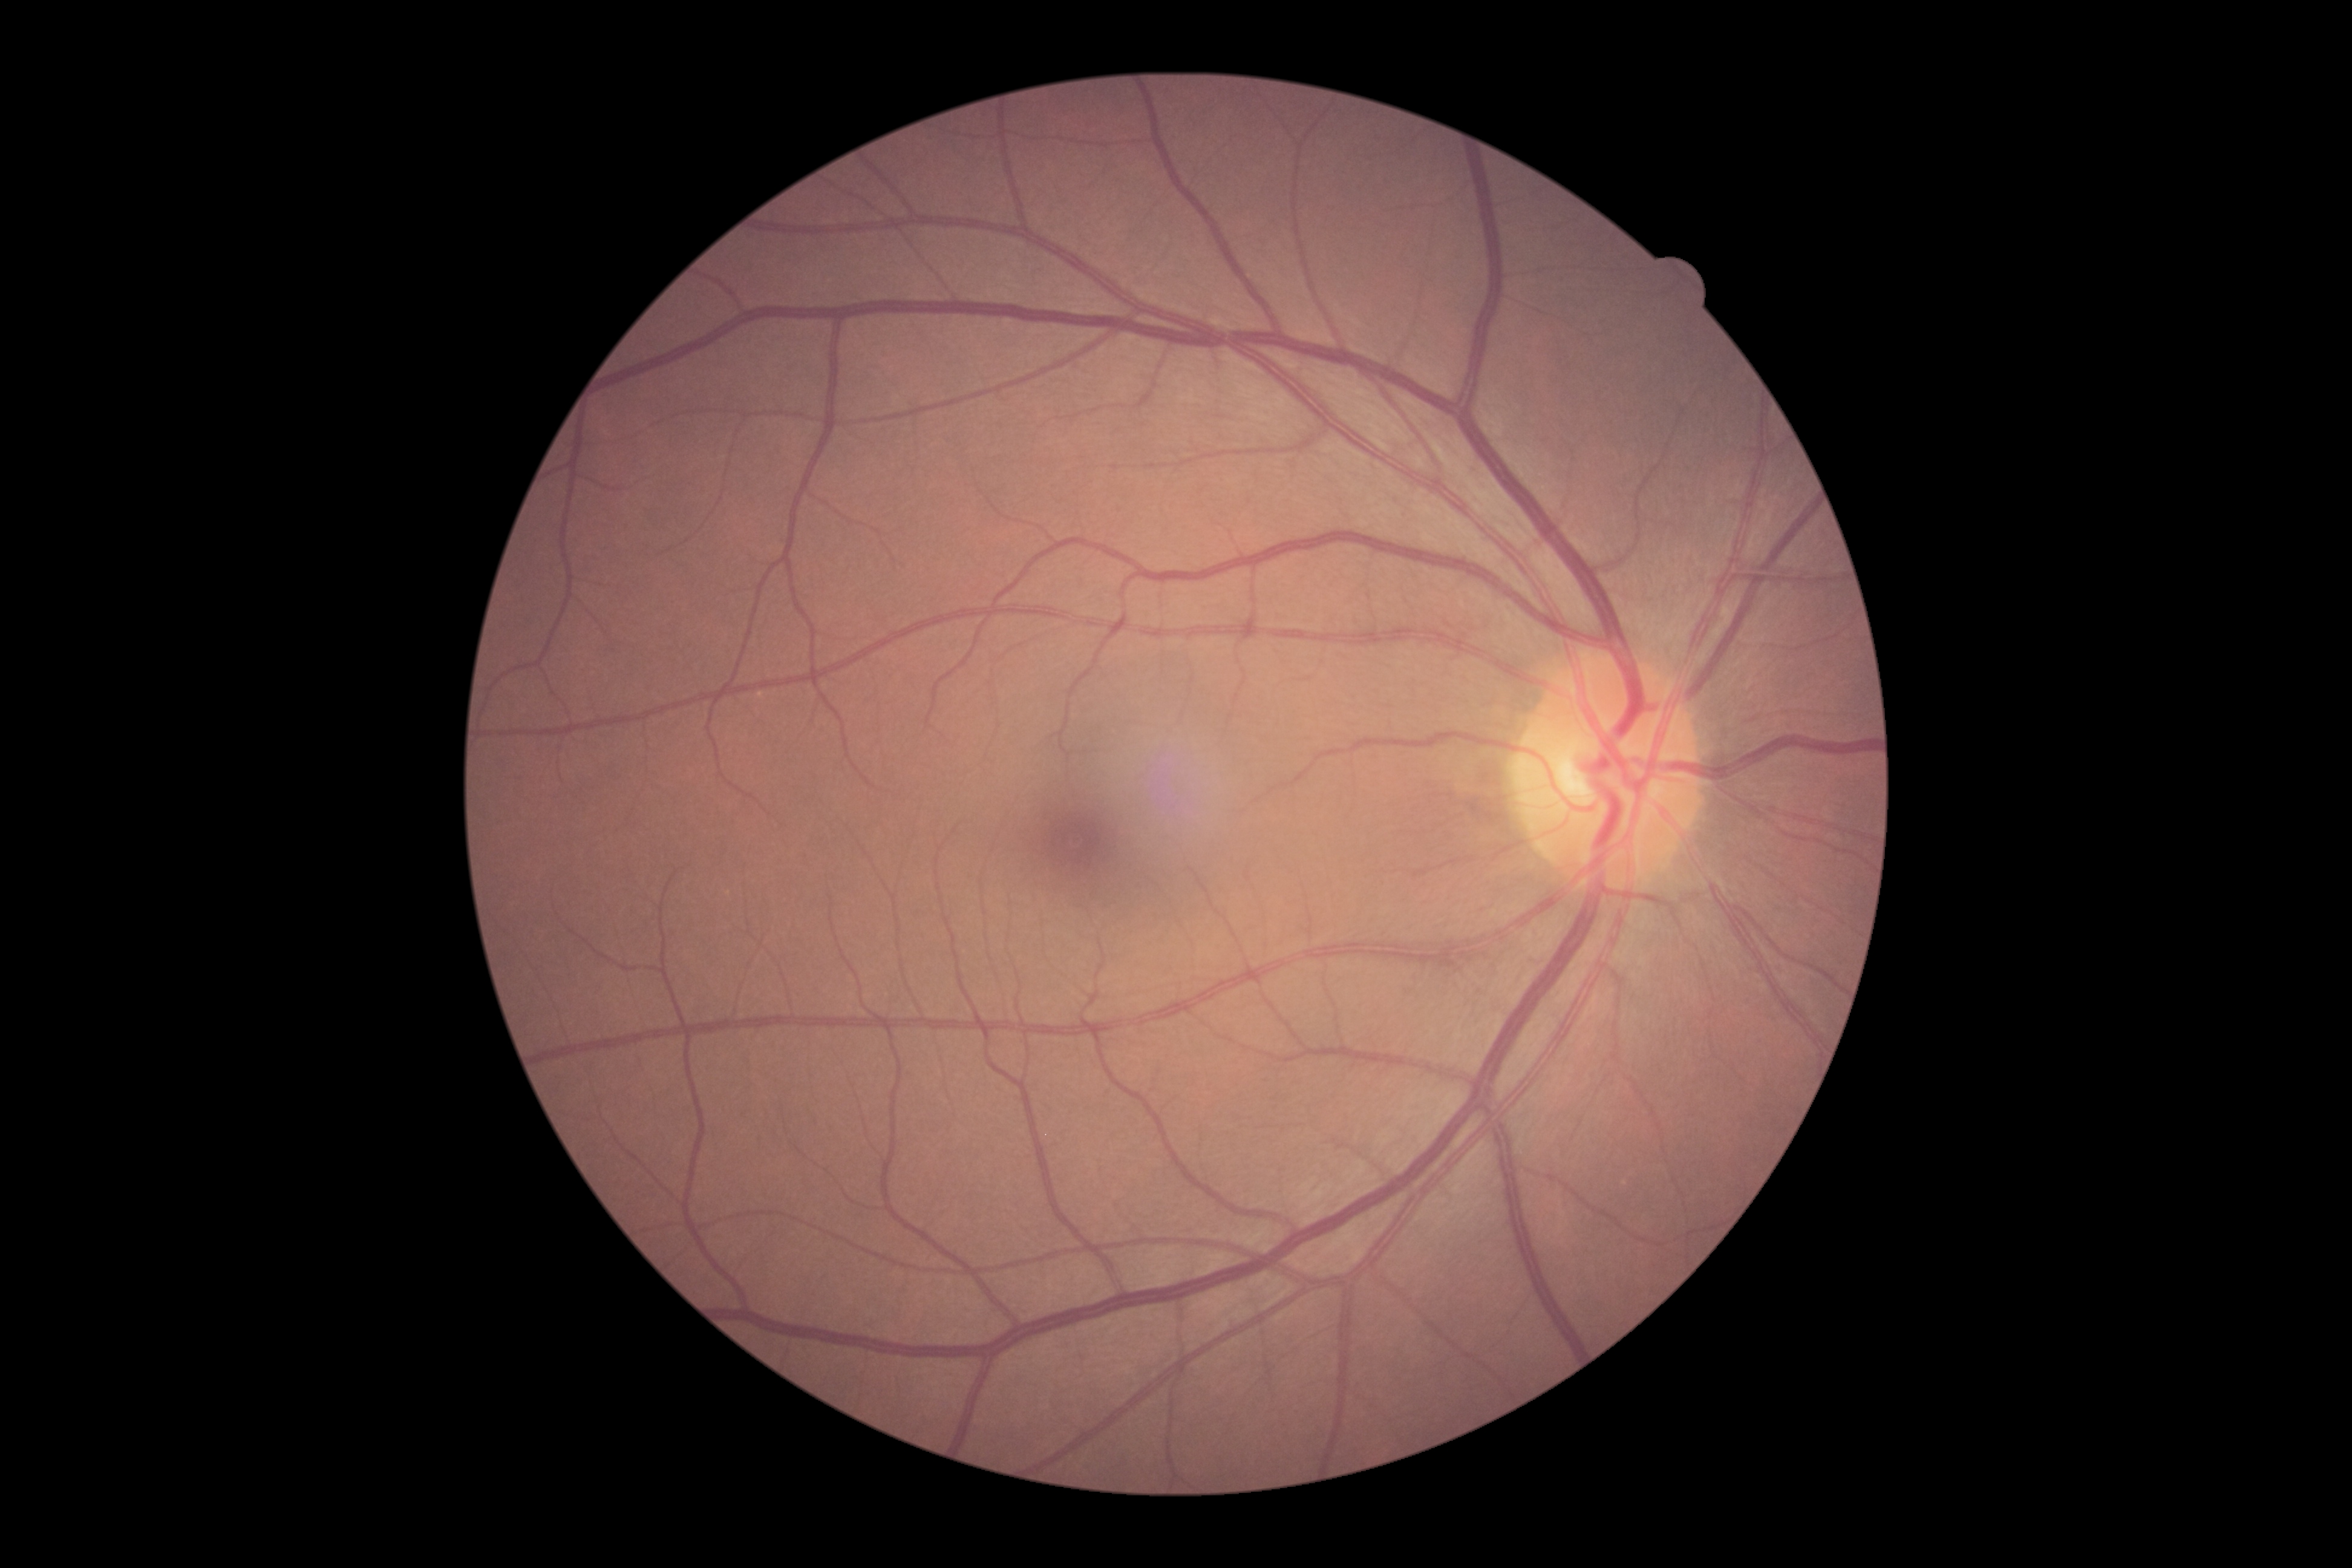
diabetic retinopathy = grade 0 (no apparent retinopathy).